FOV: 45 degrees: 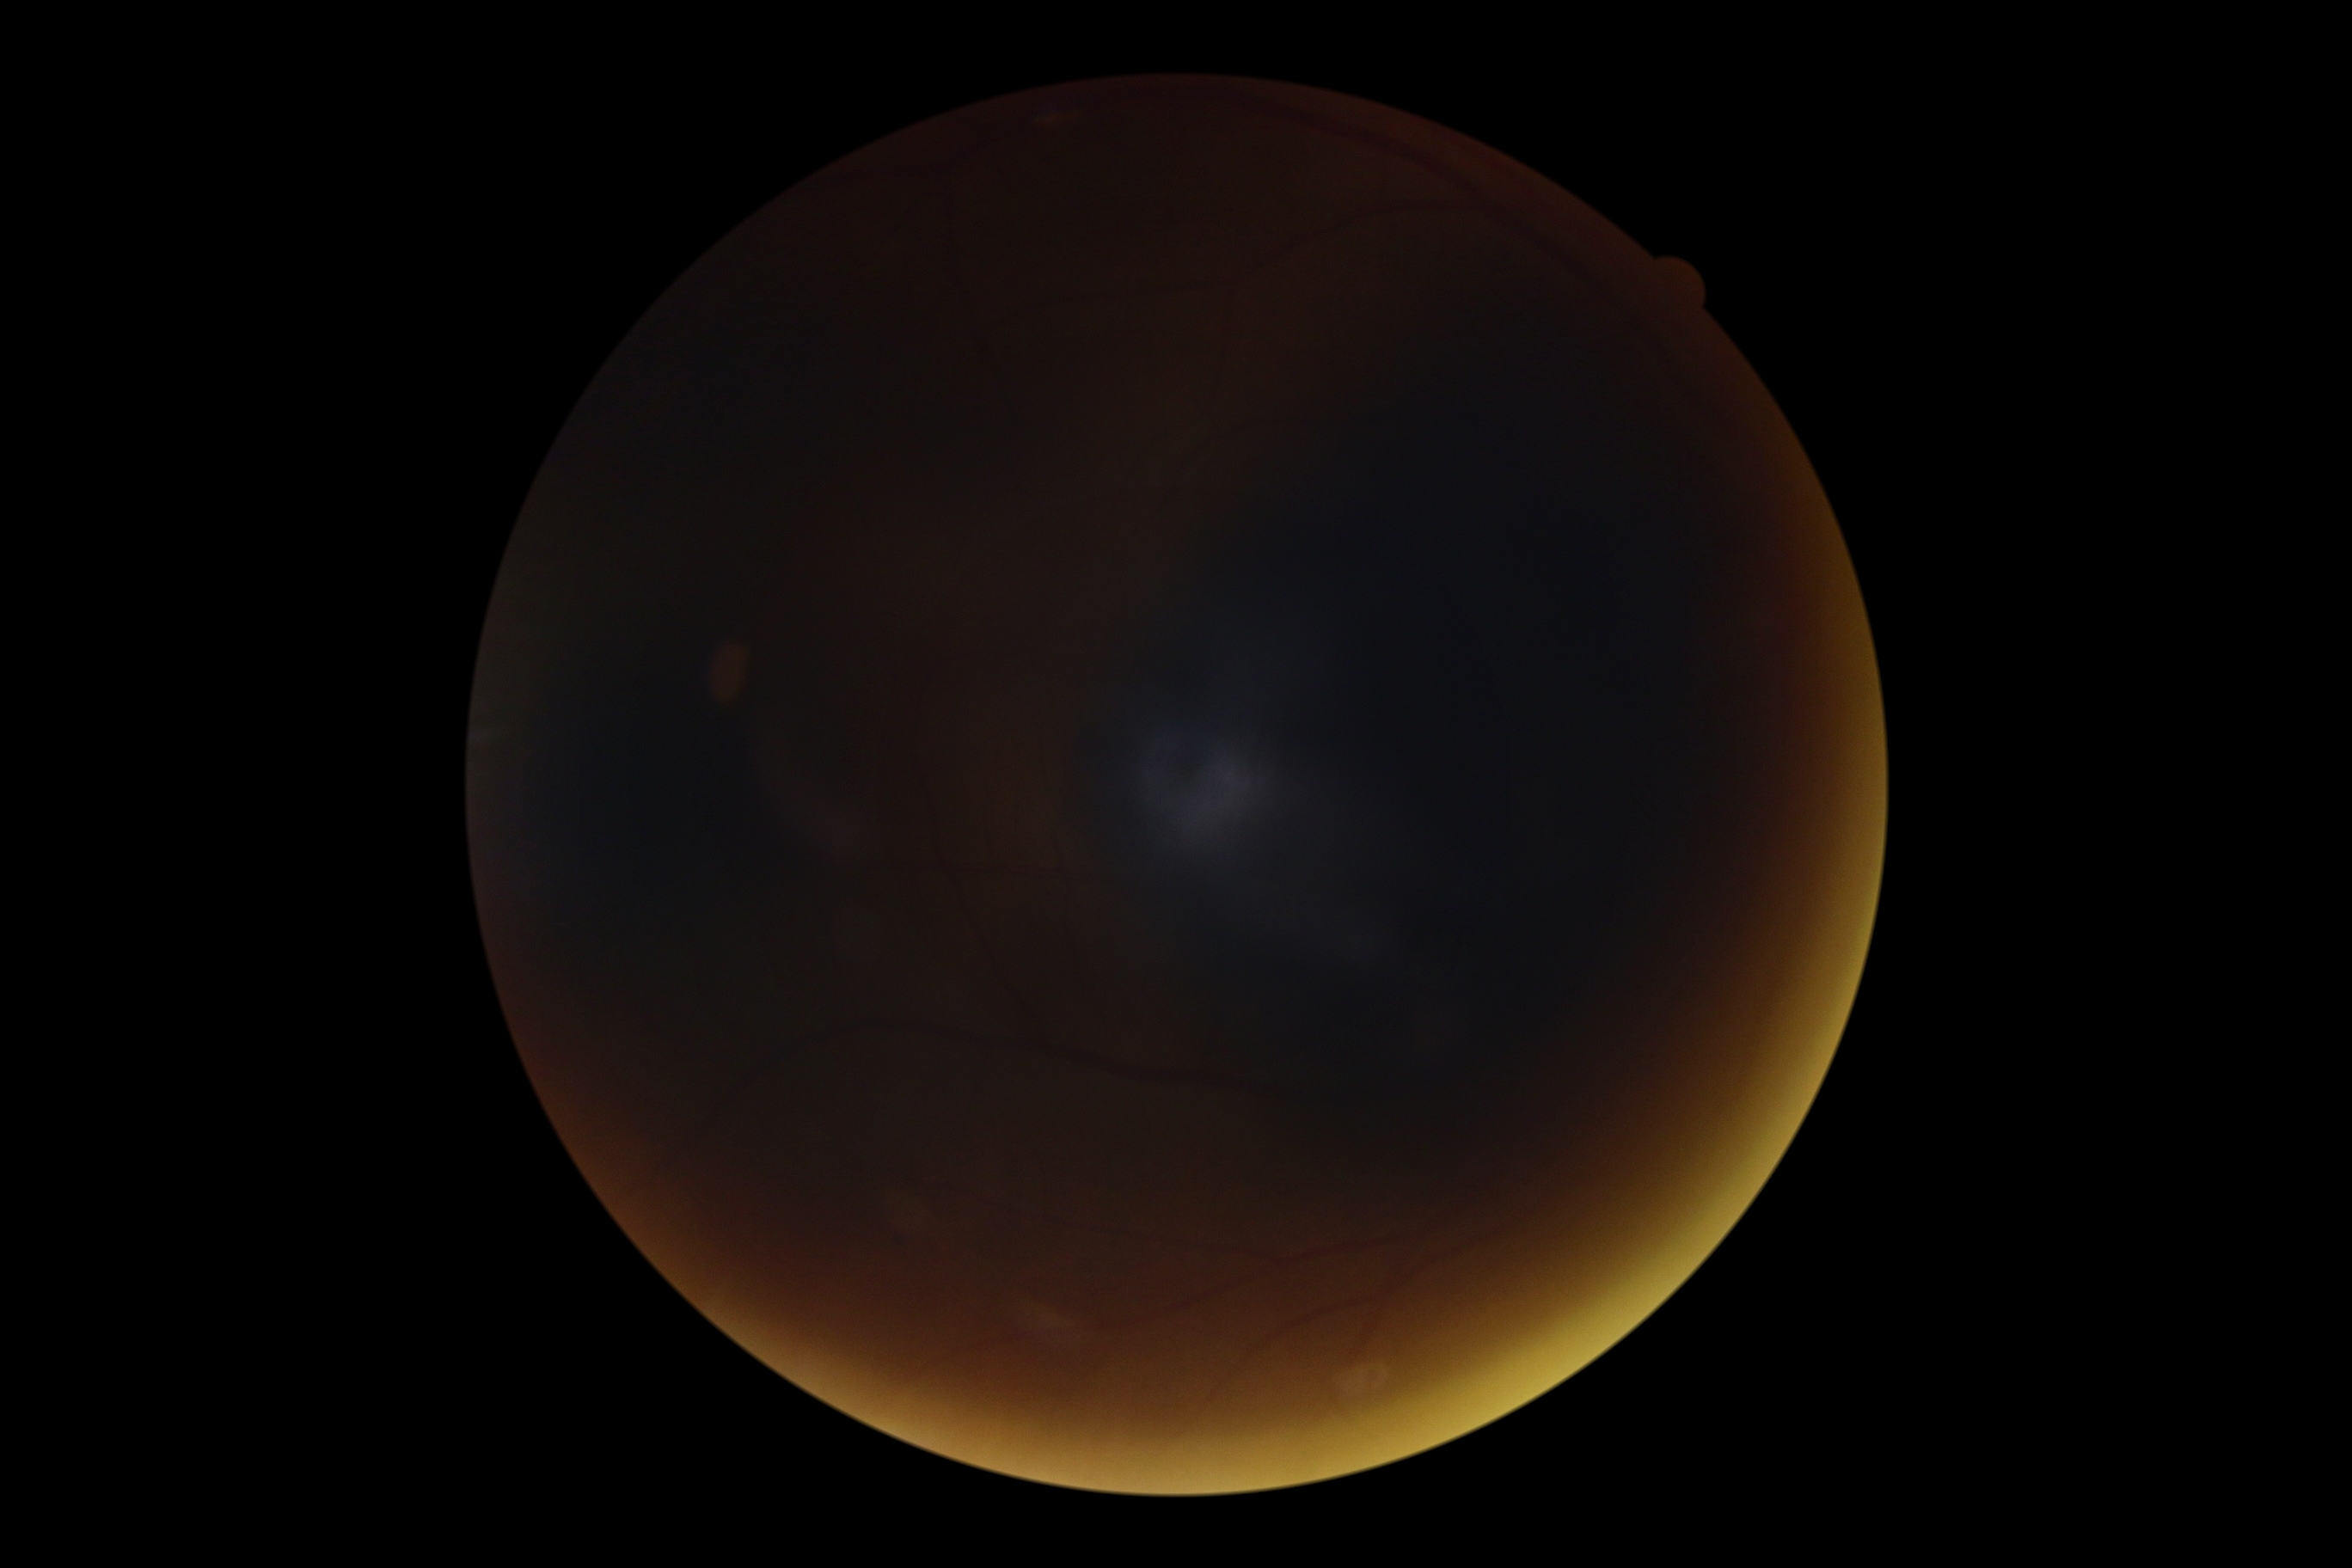
Annotations:
• retinopathy grade: ungradable